Color fundus image: 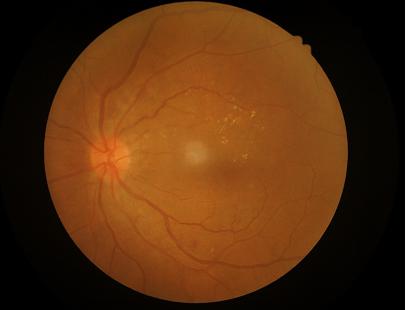
Image quality: overall: good | illumination: adequate | contrast: adequate.